640x480px · RetCam wide-field infant fundus image: 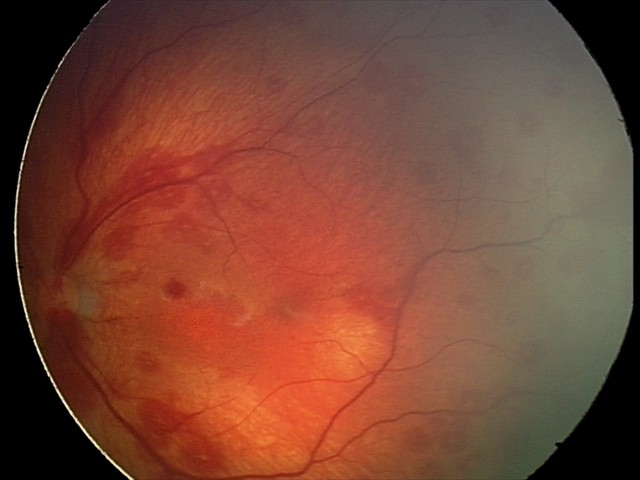
Assessment: retinal hemorrhages.